Posterior pole color fundus photograph; nonmydriatic fundus photograph: 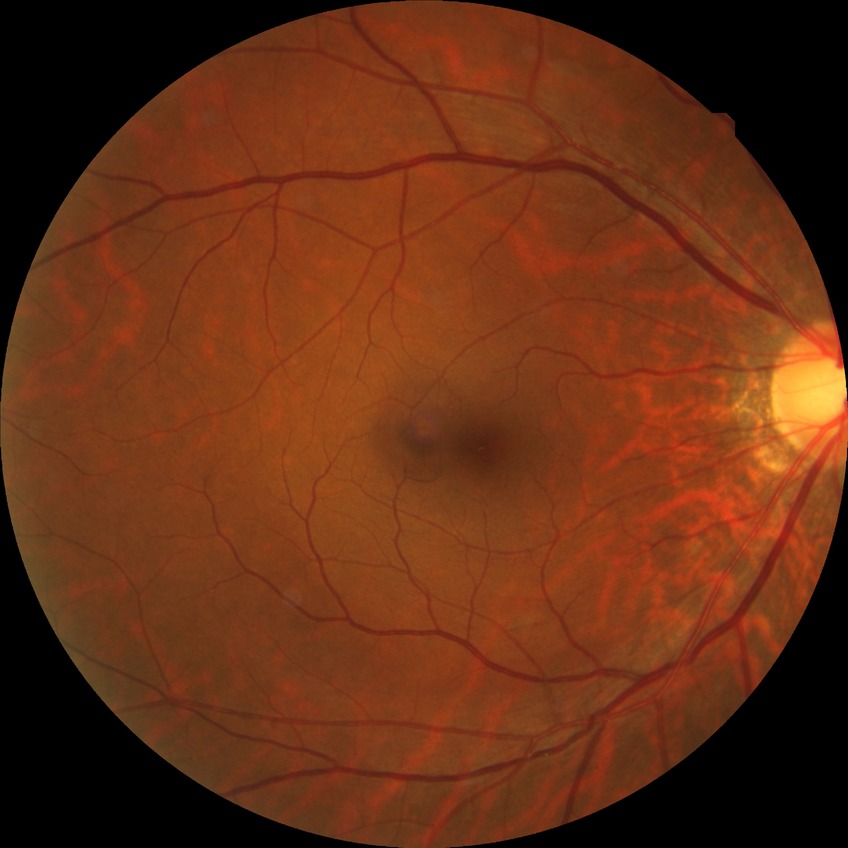 diabetic retinopathy (DR): no diabetic retinopathy (NDR).